DR severity per modified Davis staging.
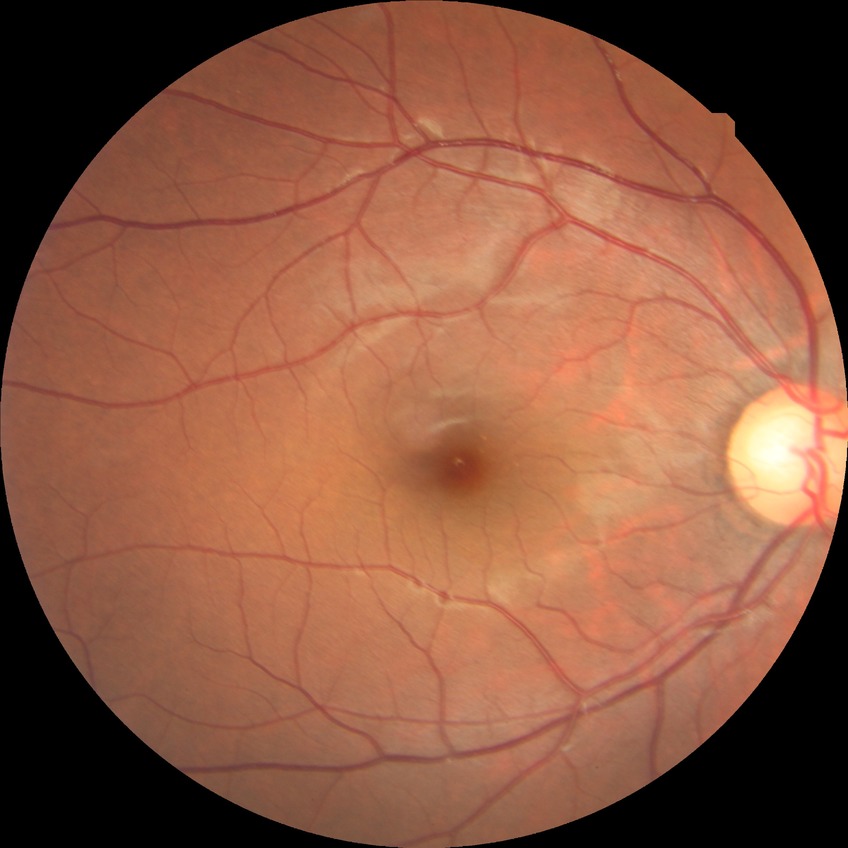

davis_grade: no diabetic retinopathy